Image size 1932x1932. Color fundus photograph — 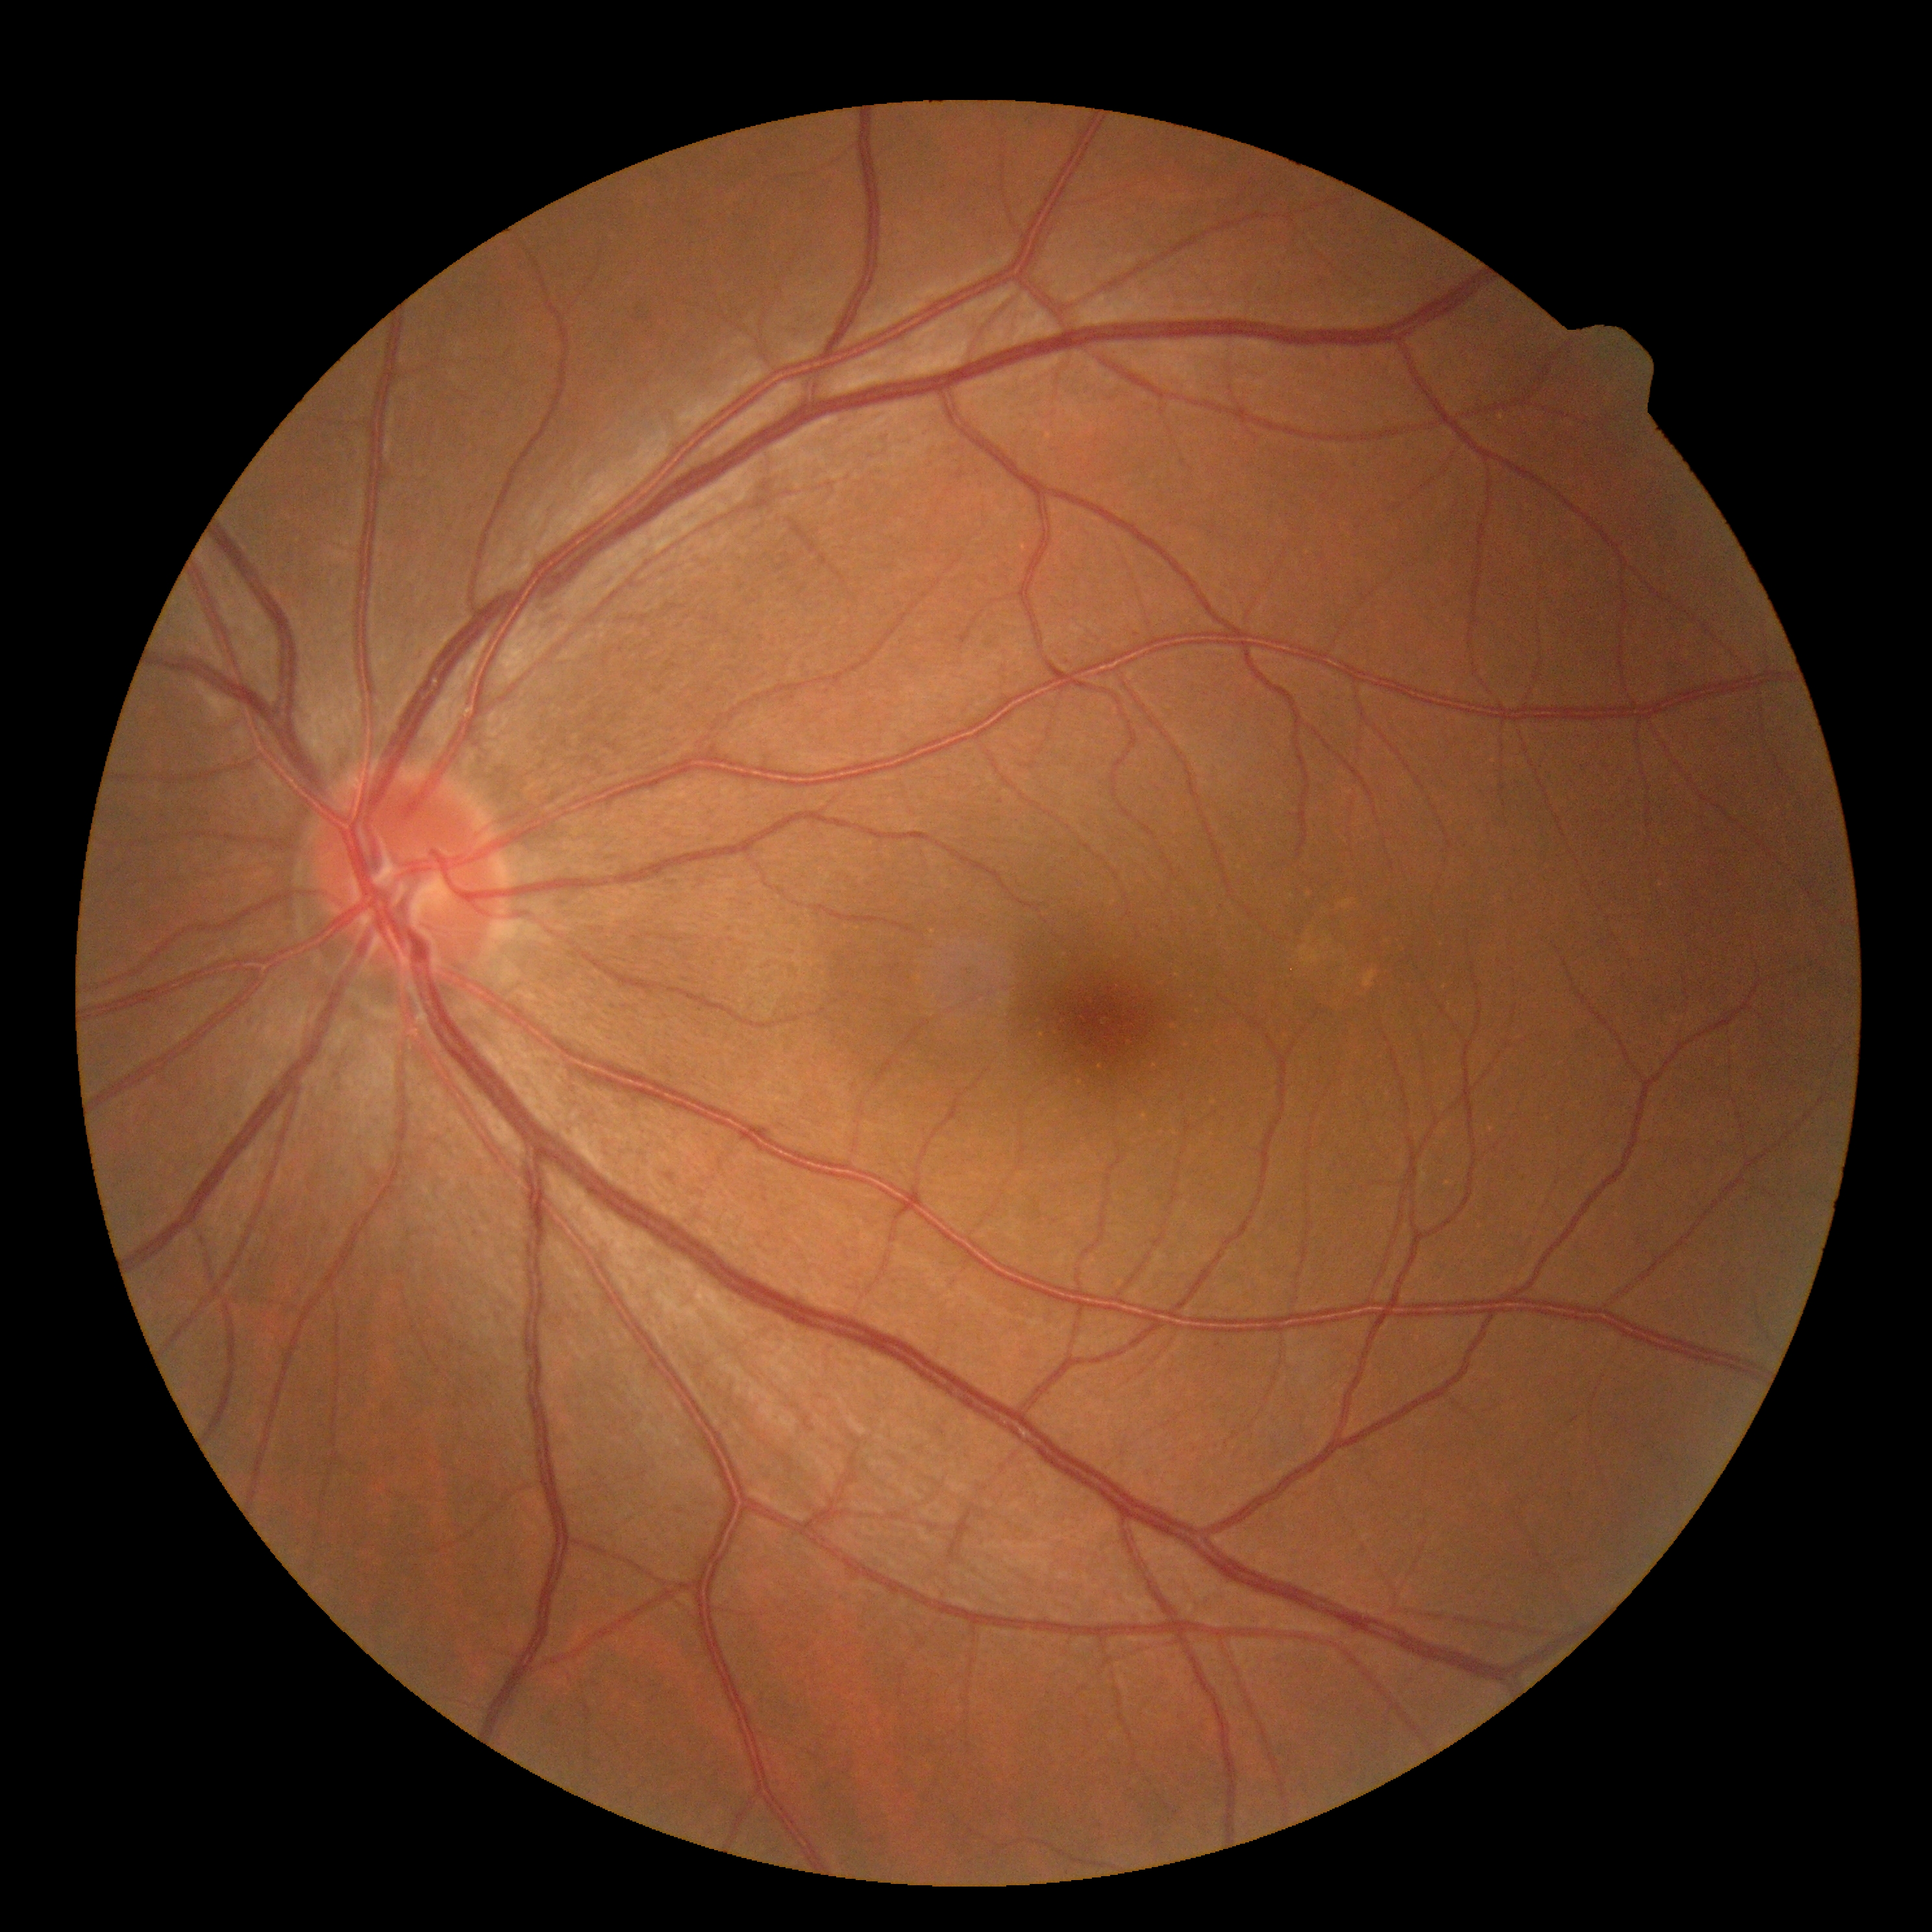 DR: 0.